DR severity per modified Davis staging.
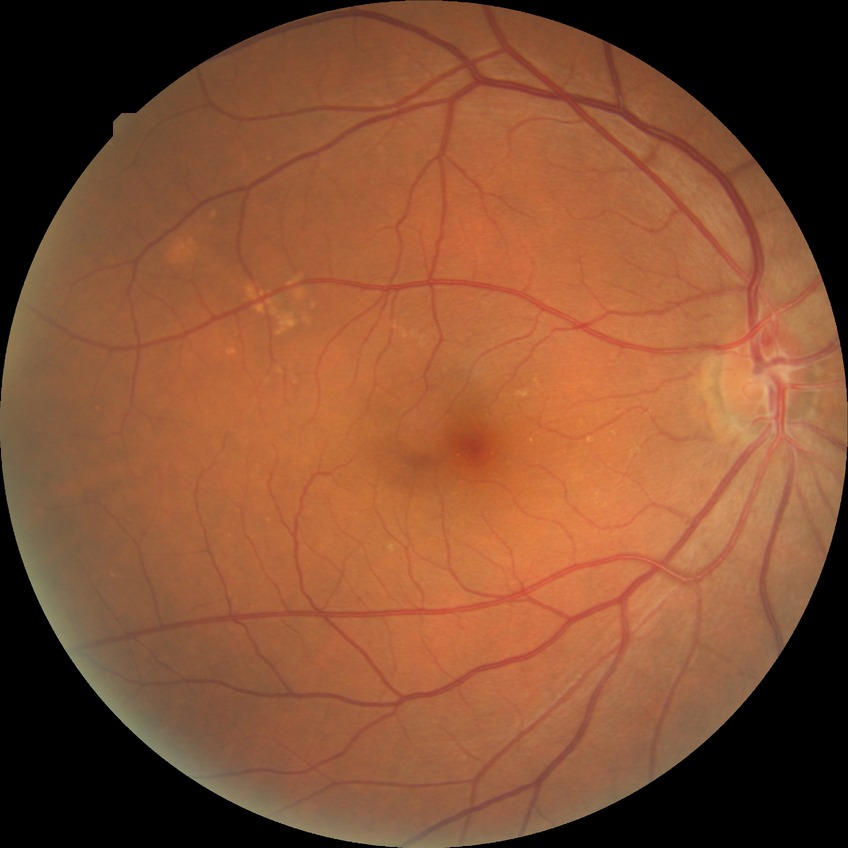

Davis grading is no diabetic retinopathy.